CFP · field includes the optic disc and macula
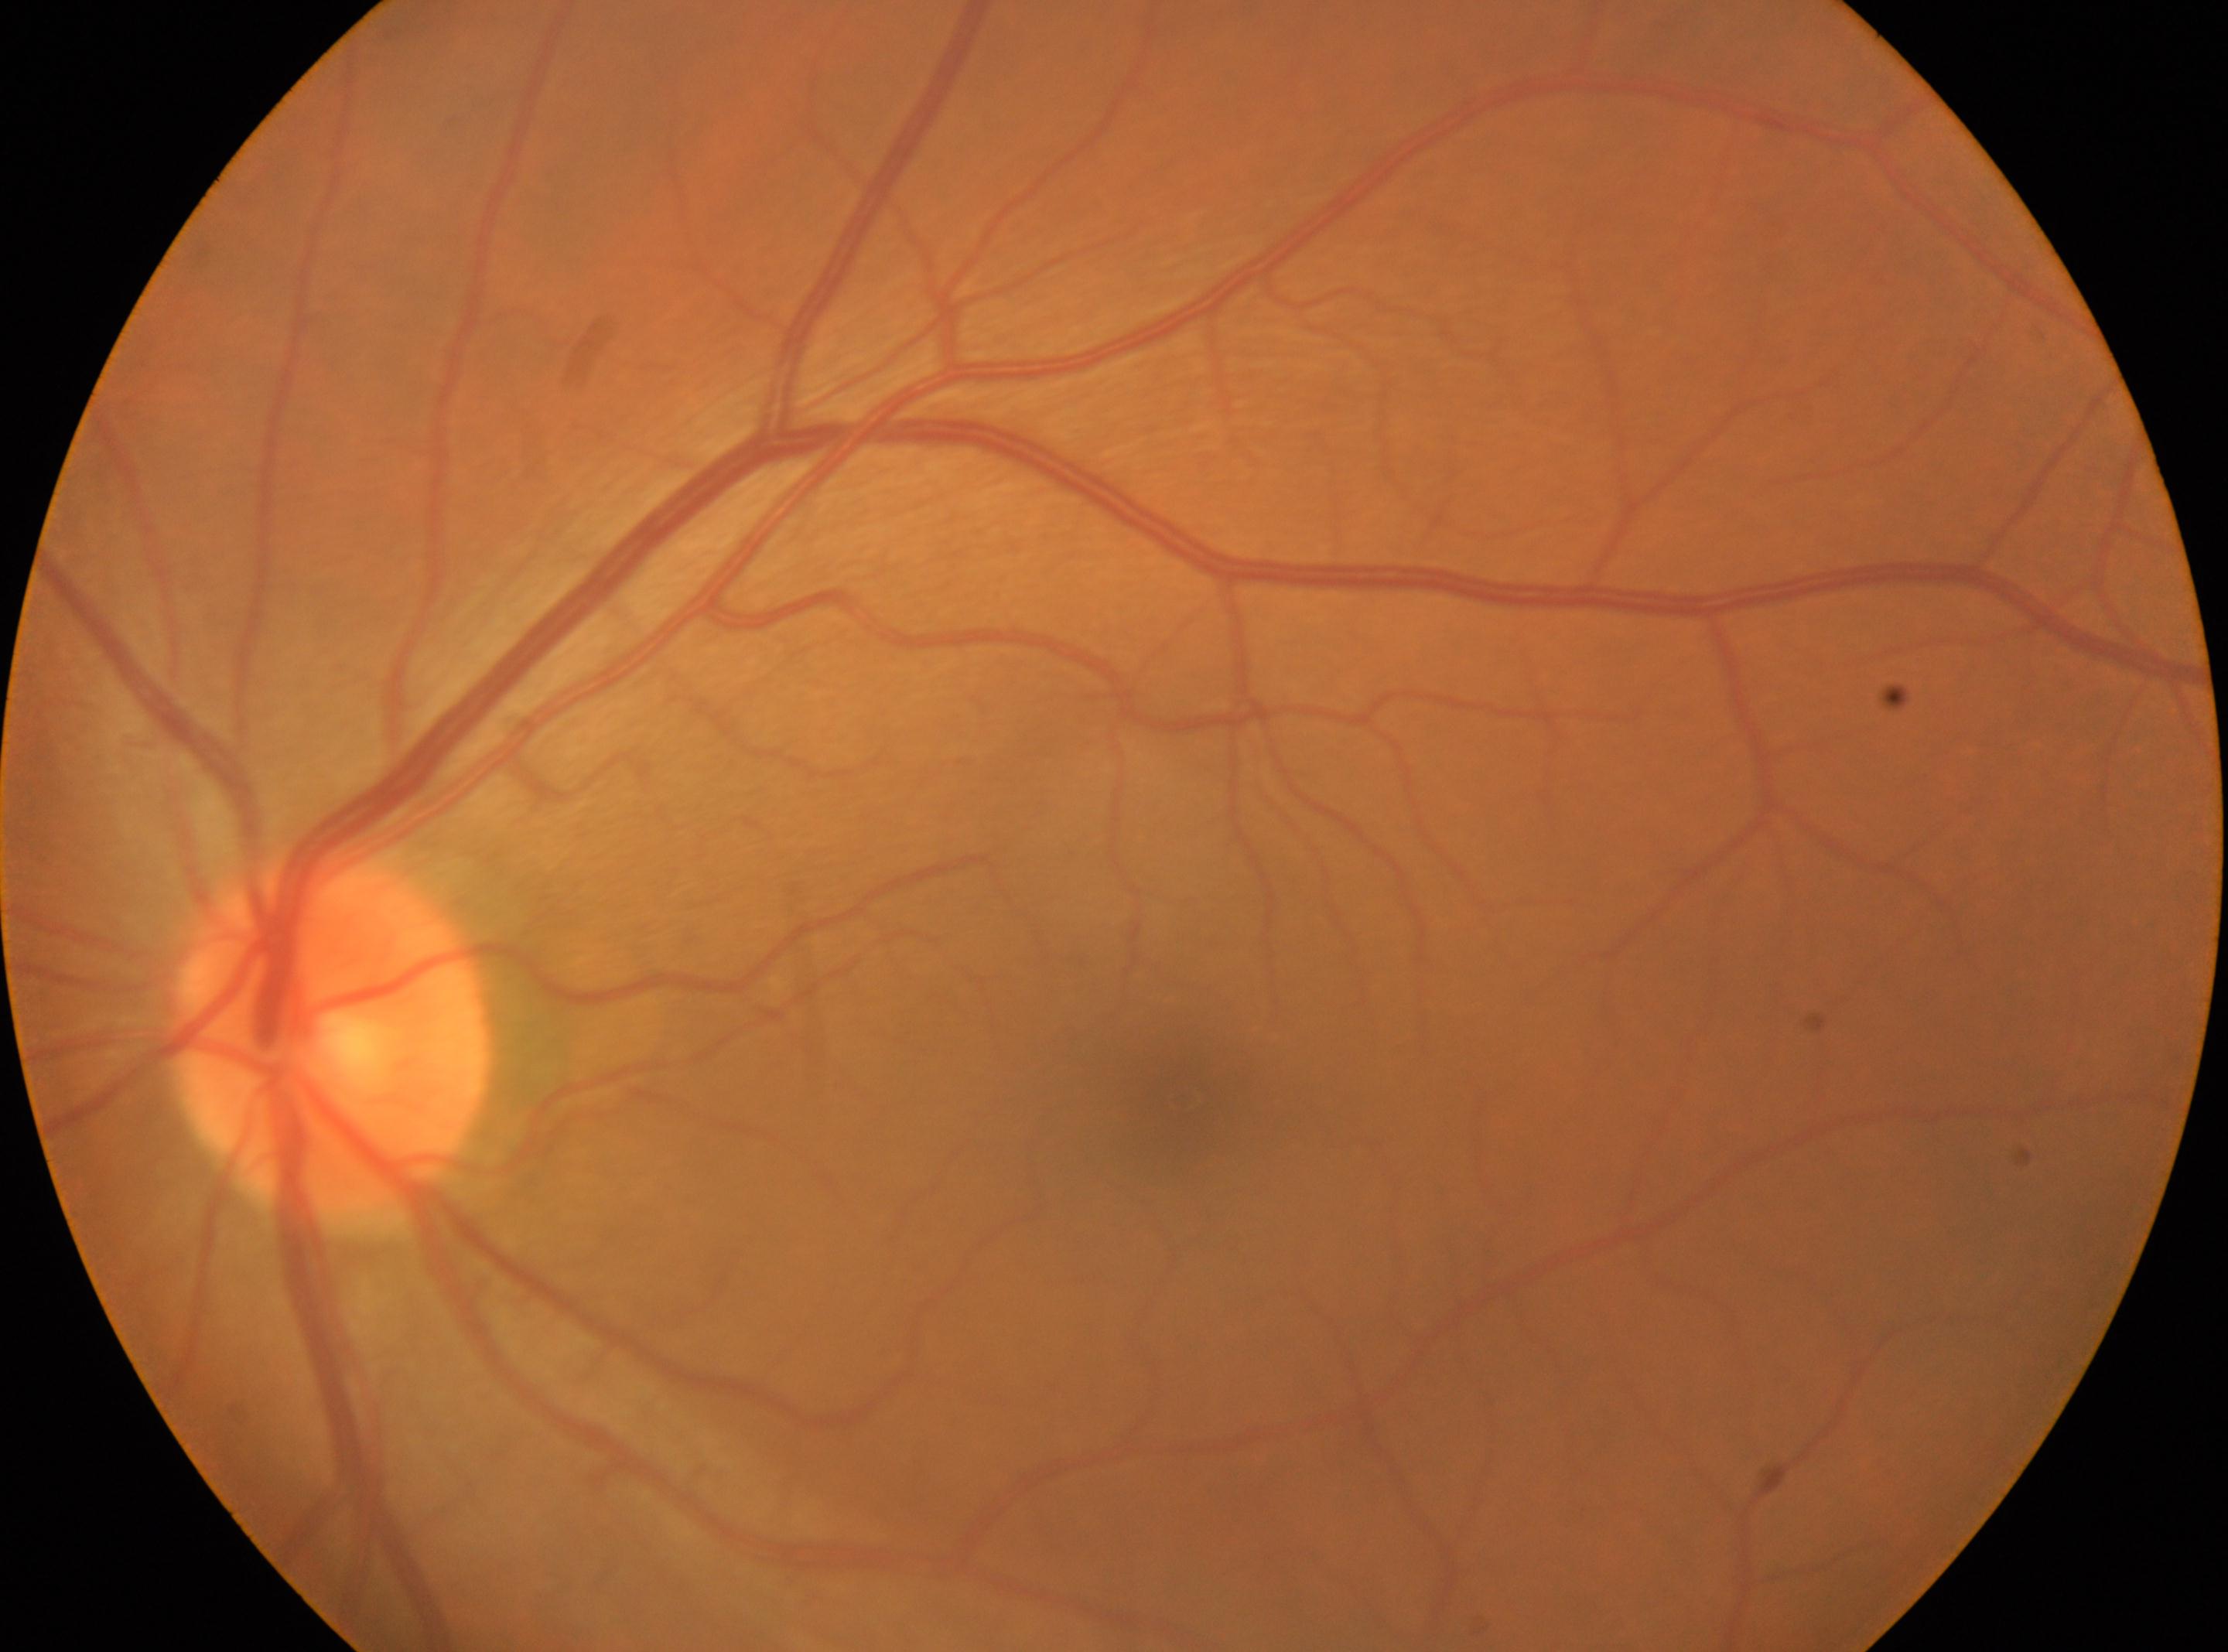 Diabetic retinopathy grade: 0 (no apparent retinopathy).
Optic disc: (x: 328, y: 1035).
Macula center located at (x: 1182, y: 1100).
The image shows the left eye.